Color fundus photograph — 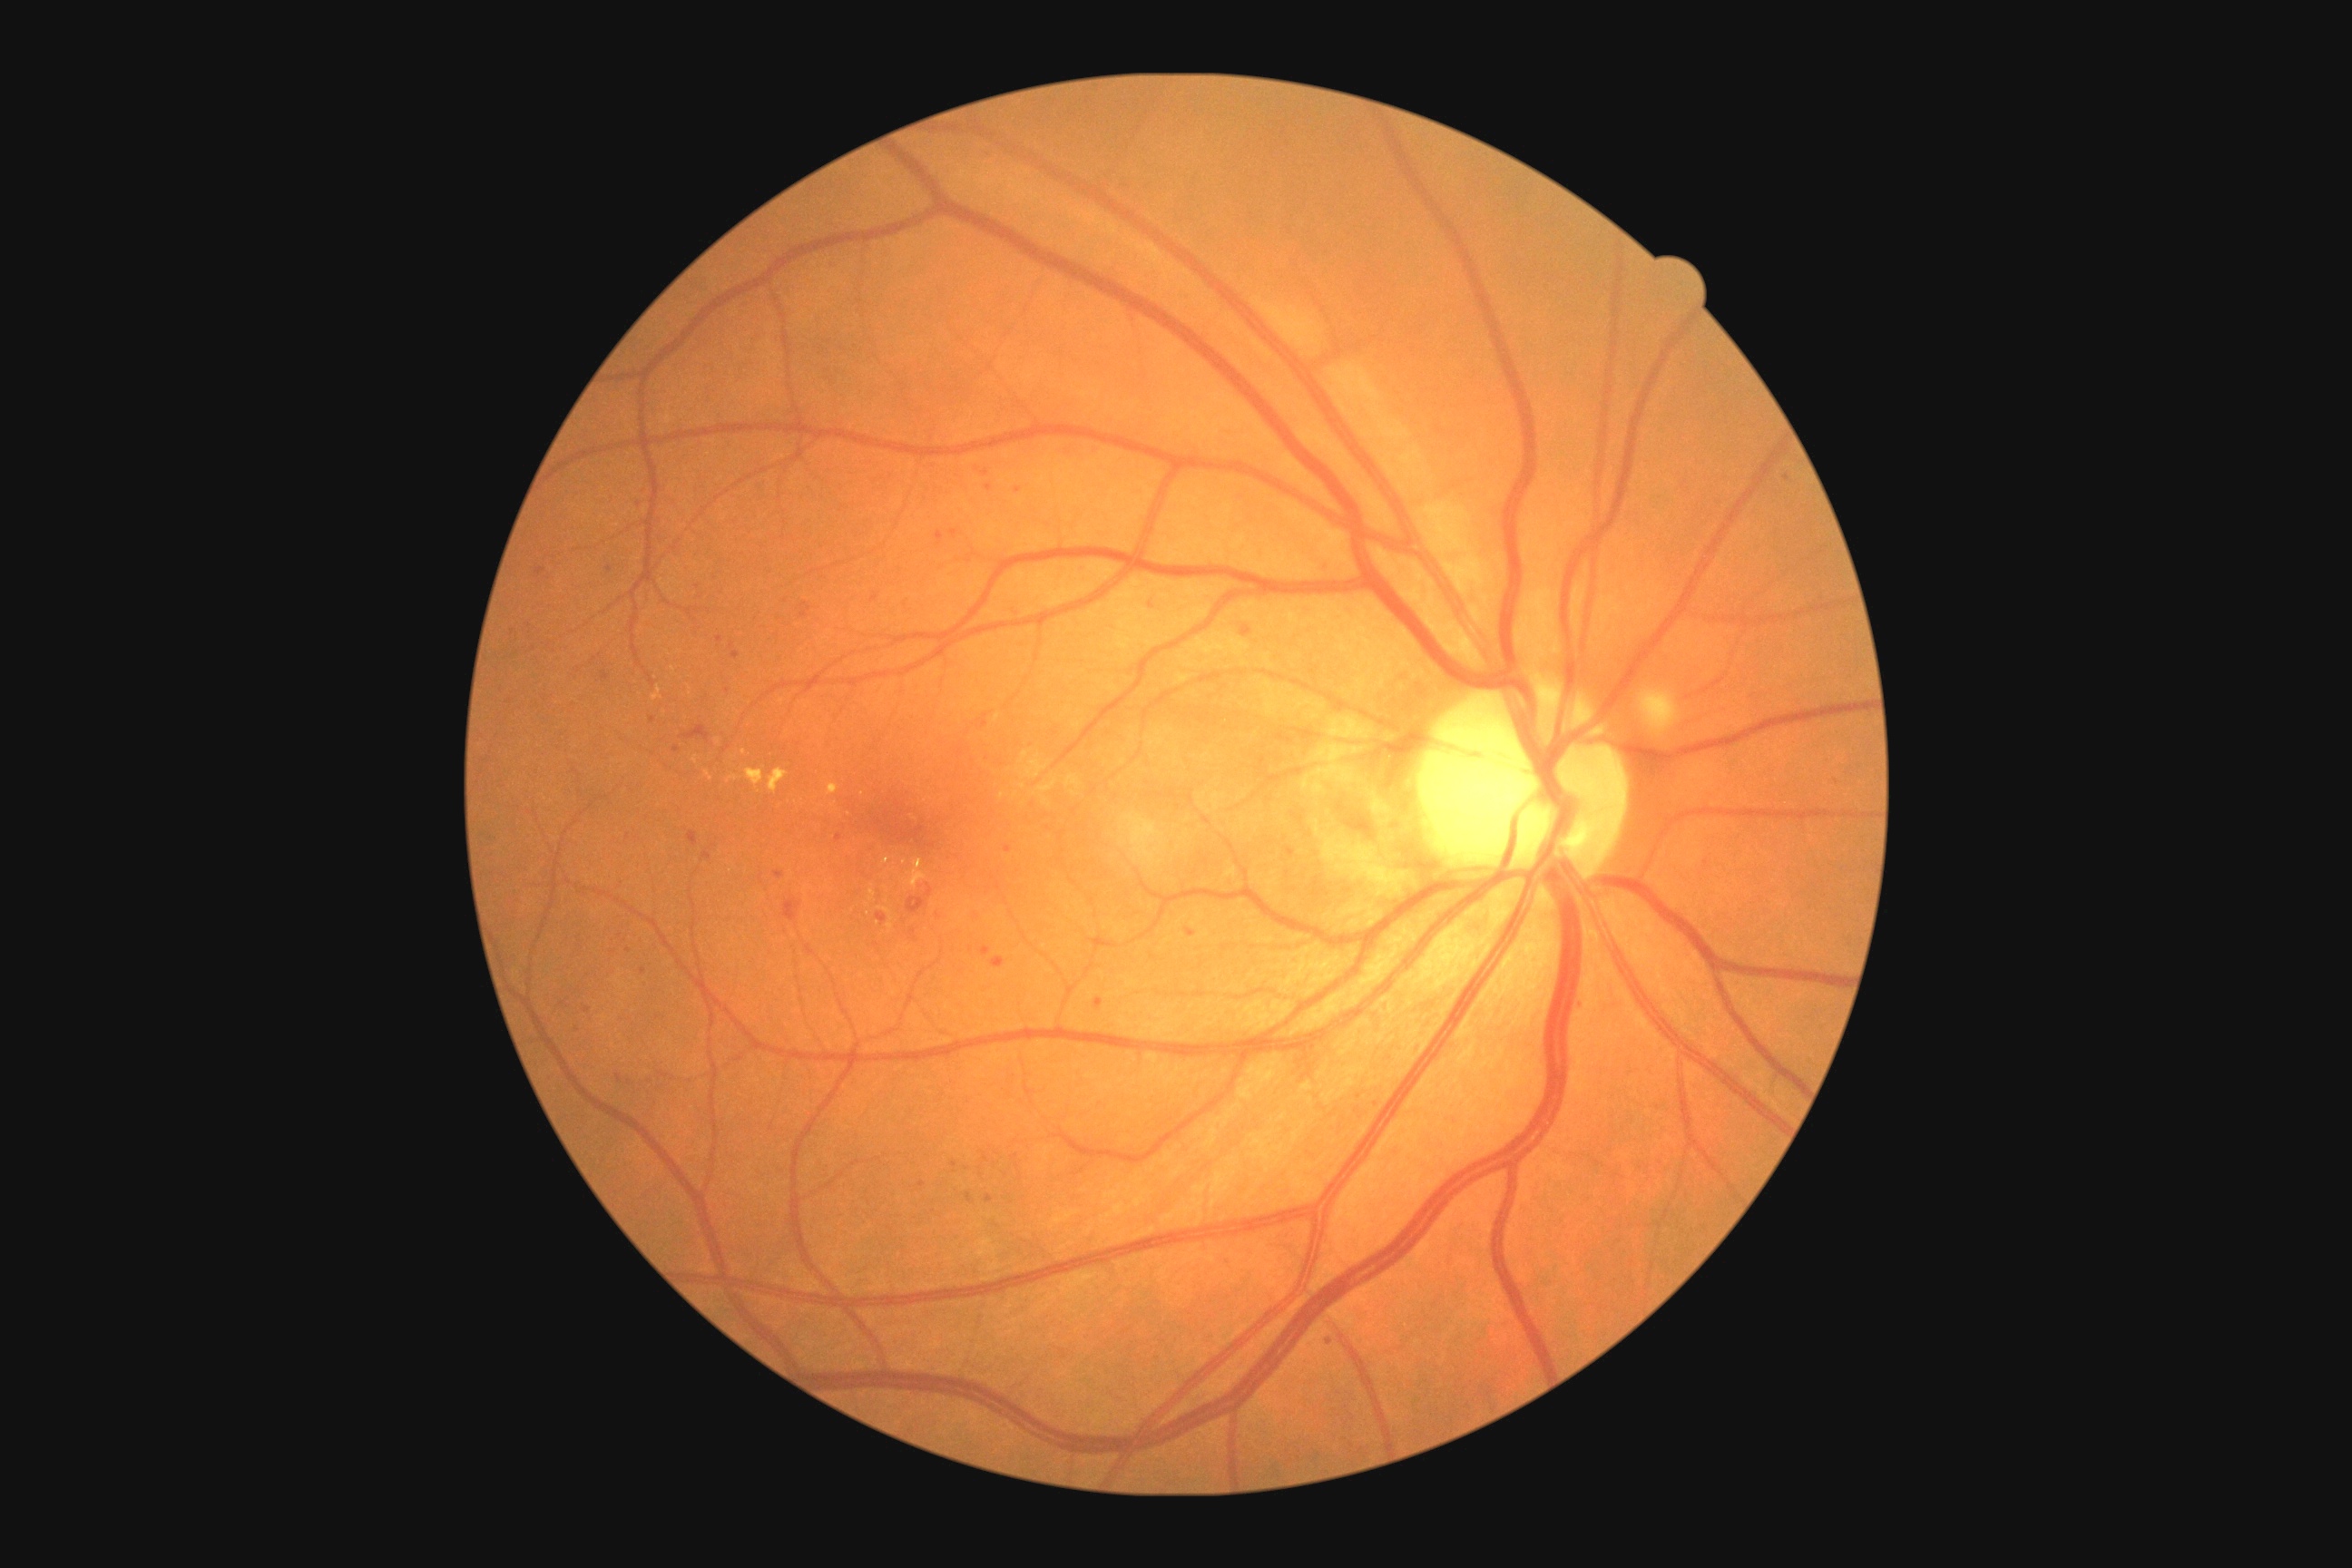 Diabetic retinopathy (DR) is 2
Representative lesions:
microaneurysms (MAs) (more not shown): box(799, 612, 808, 618); box(936, 531, 945, 547); box(1320, 560, 1326, 569); box(1242, 627, 1253, 638); box(985, 153, 992, 161); box(981, 946, 990, 957); box(774, 872, 785, 879); box(801, 603, 810, 612); box(950, 531, 959, 538)
MAs (small, approximate centers) near (1009; 850); (640; 504); (609; 570); (644; 971); (1787; 479); (720; 639); (939; 915)